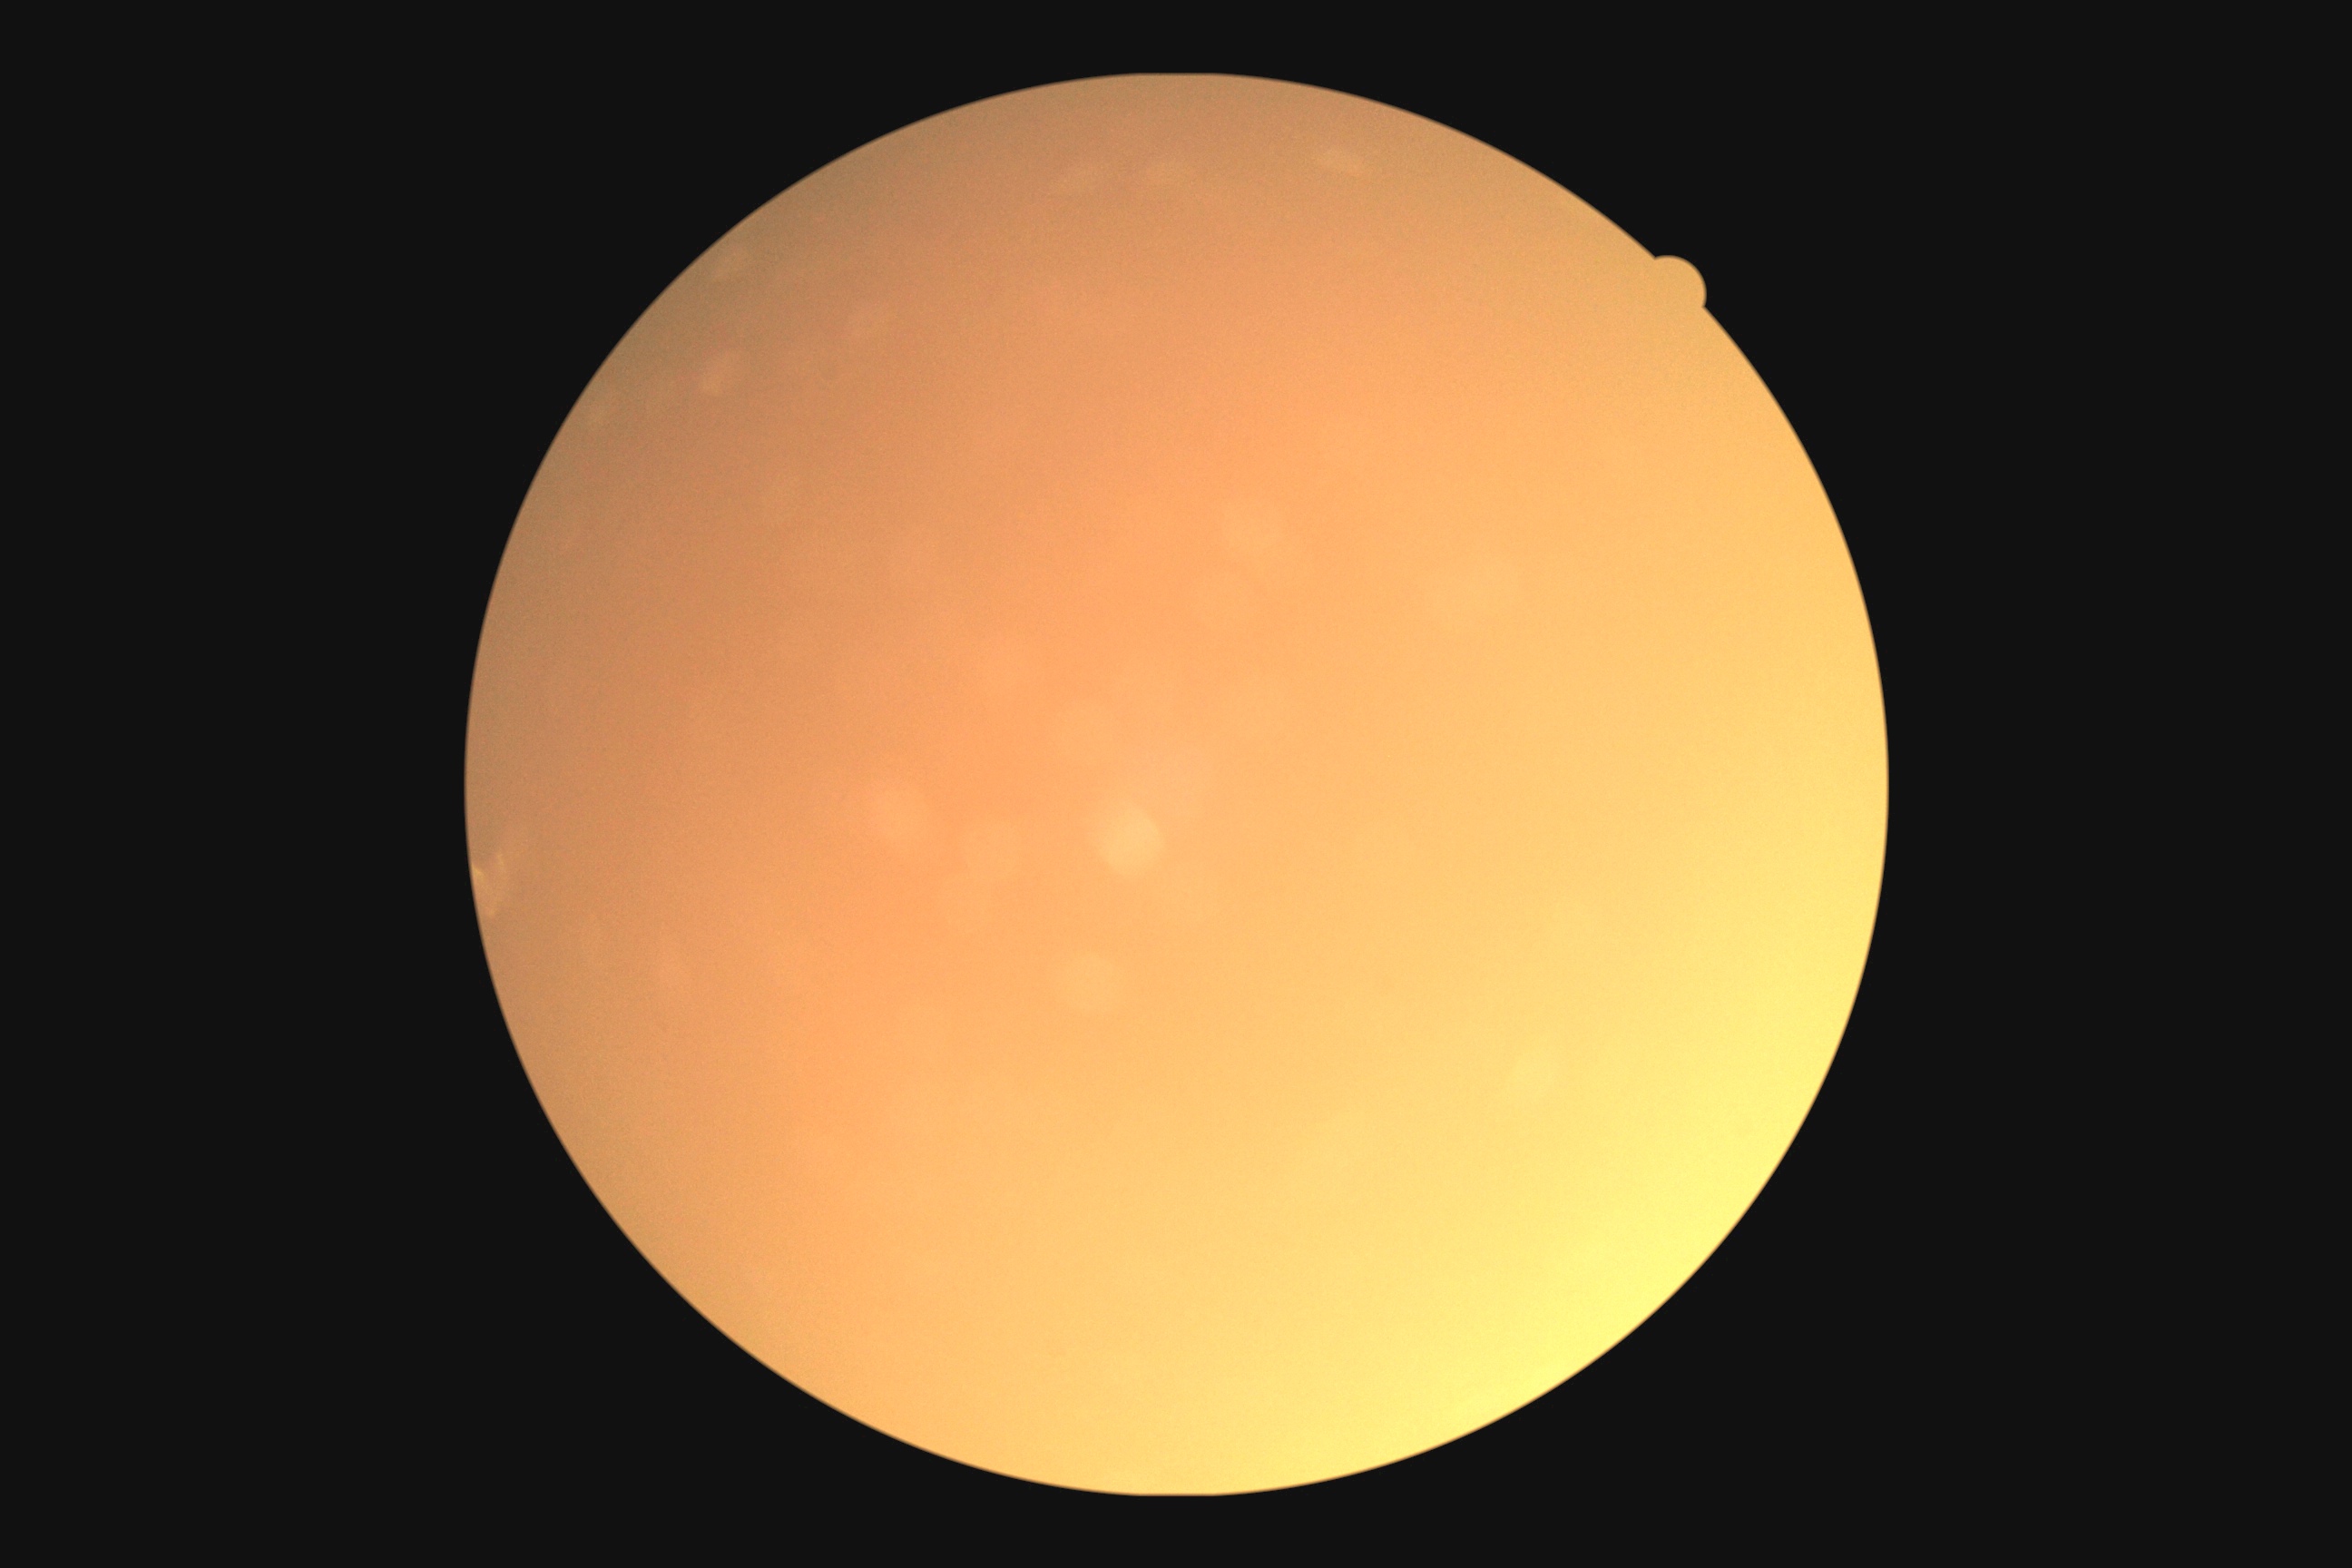 DR is ungradable due to poor image quality. Ungradable image — DR severity cannot be determined.